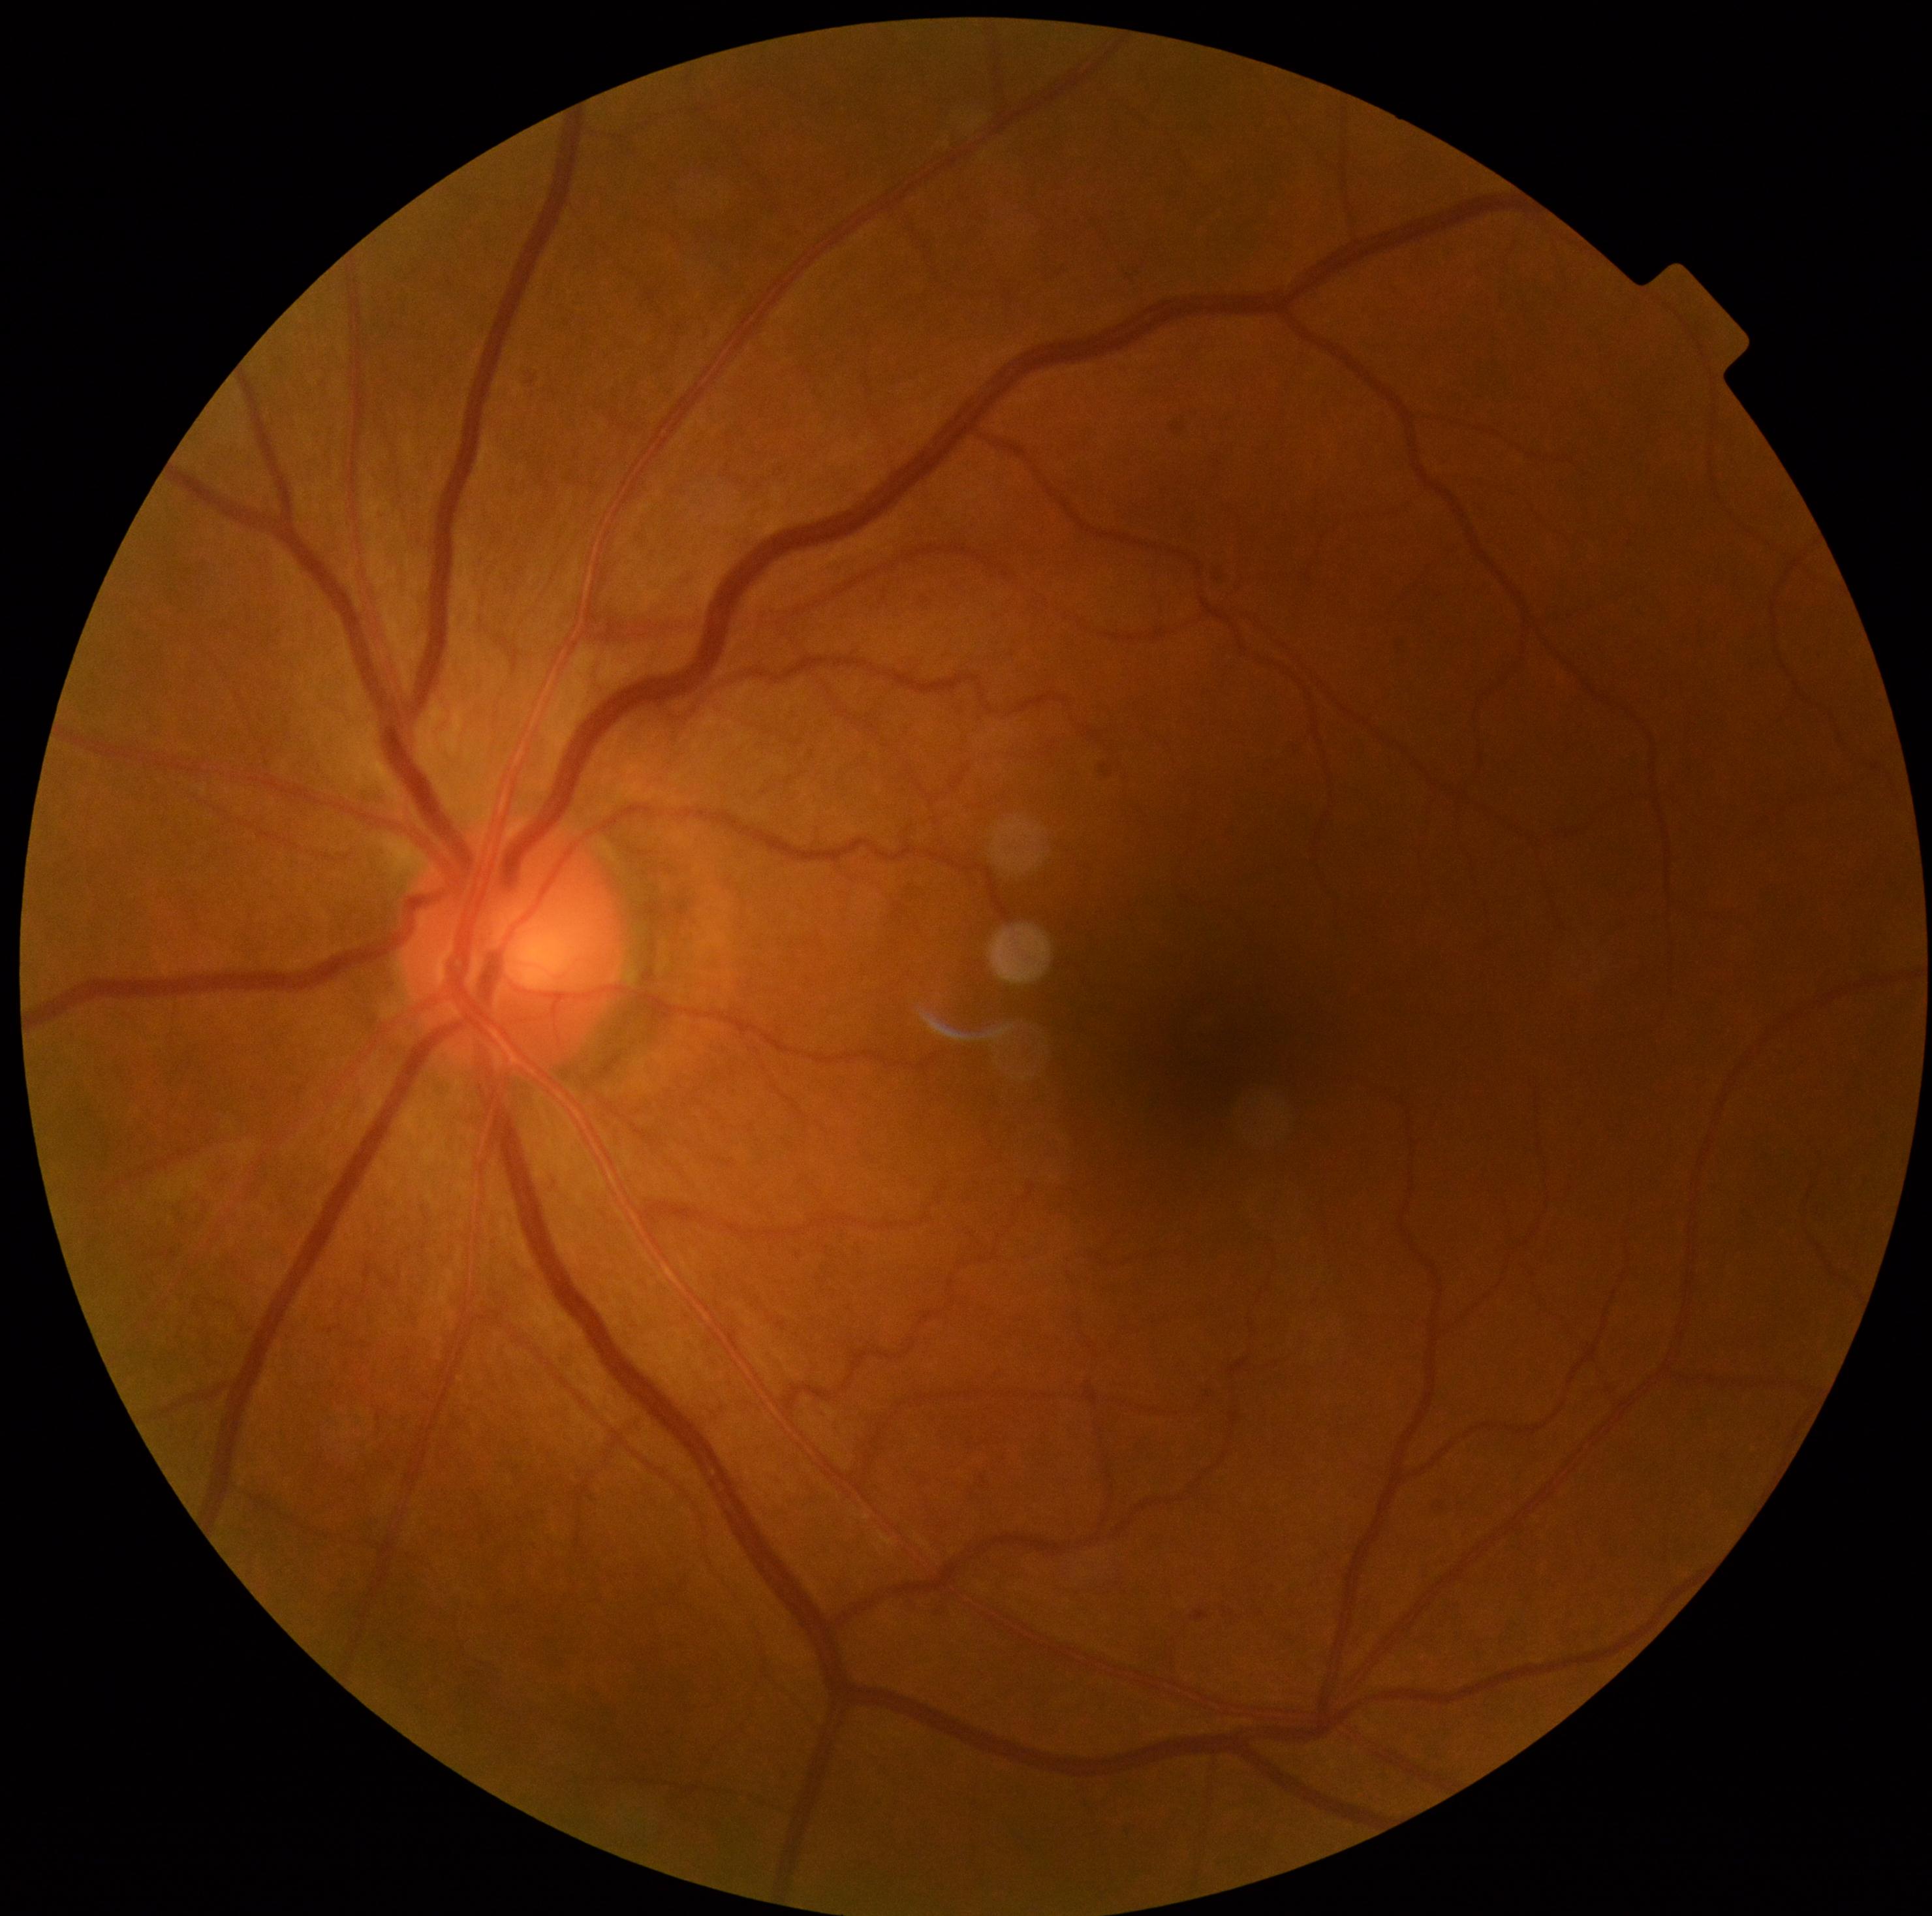
Diabetic retinopathy grade is 1/4.